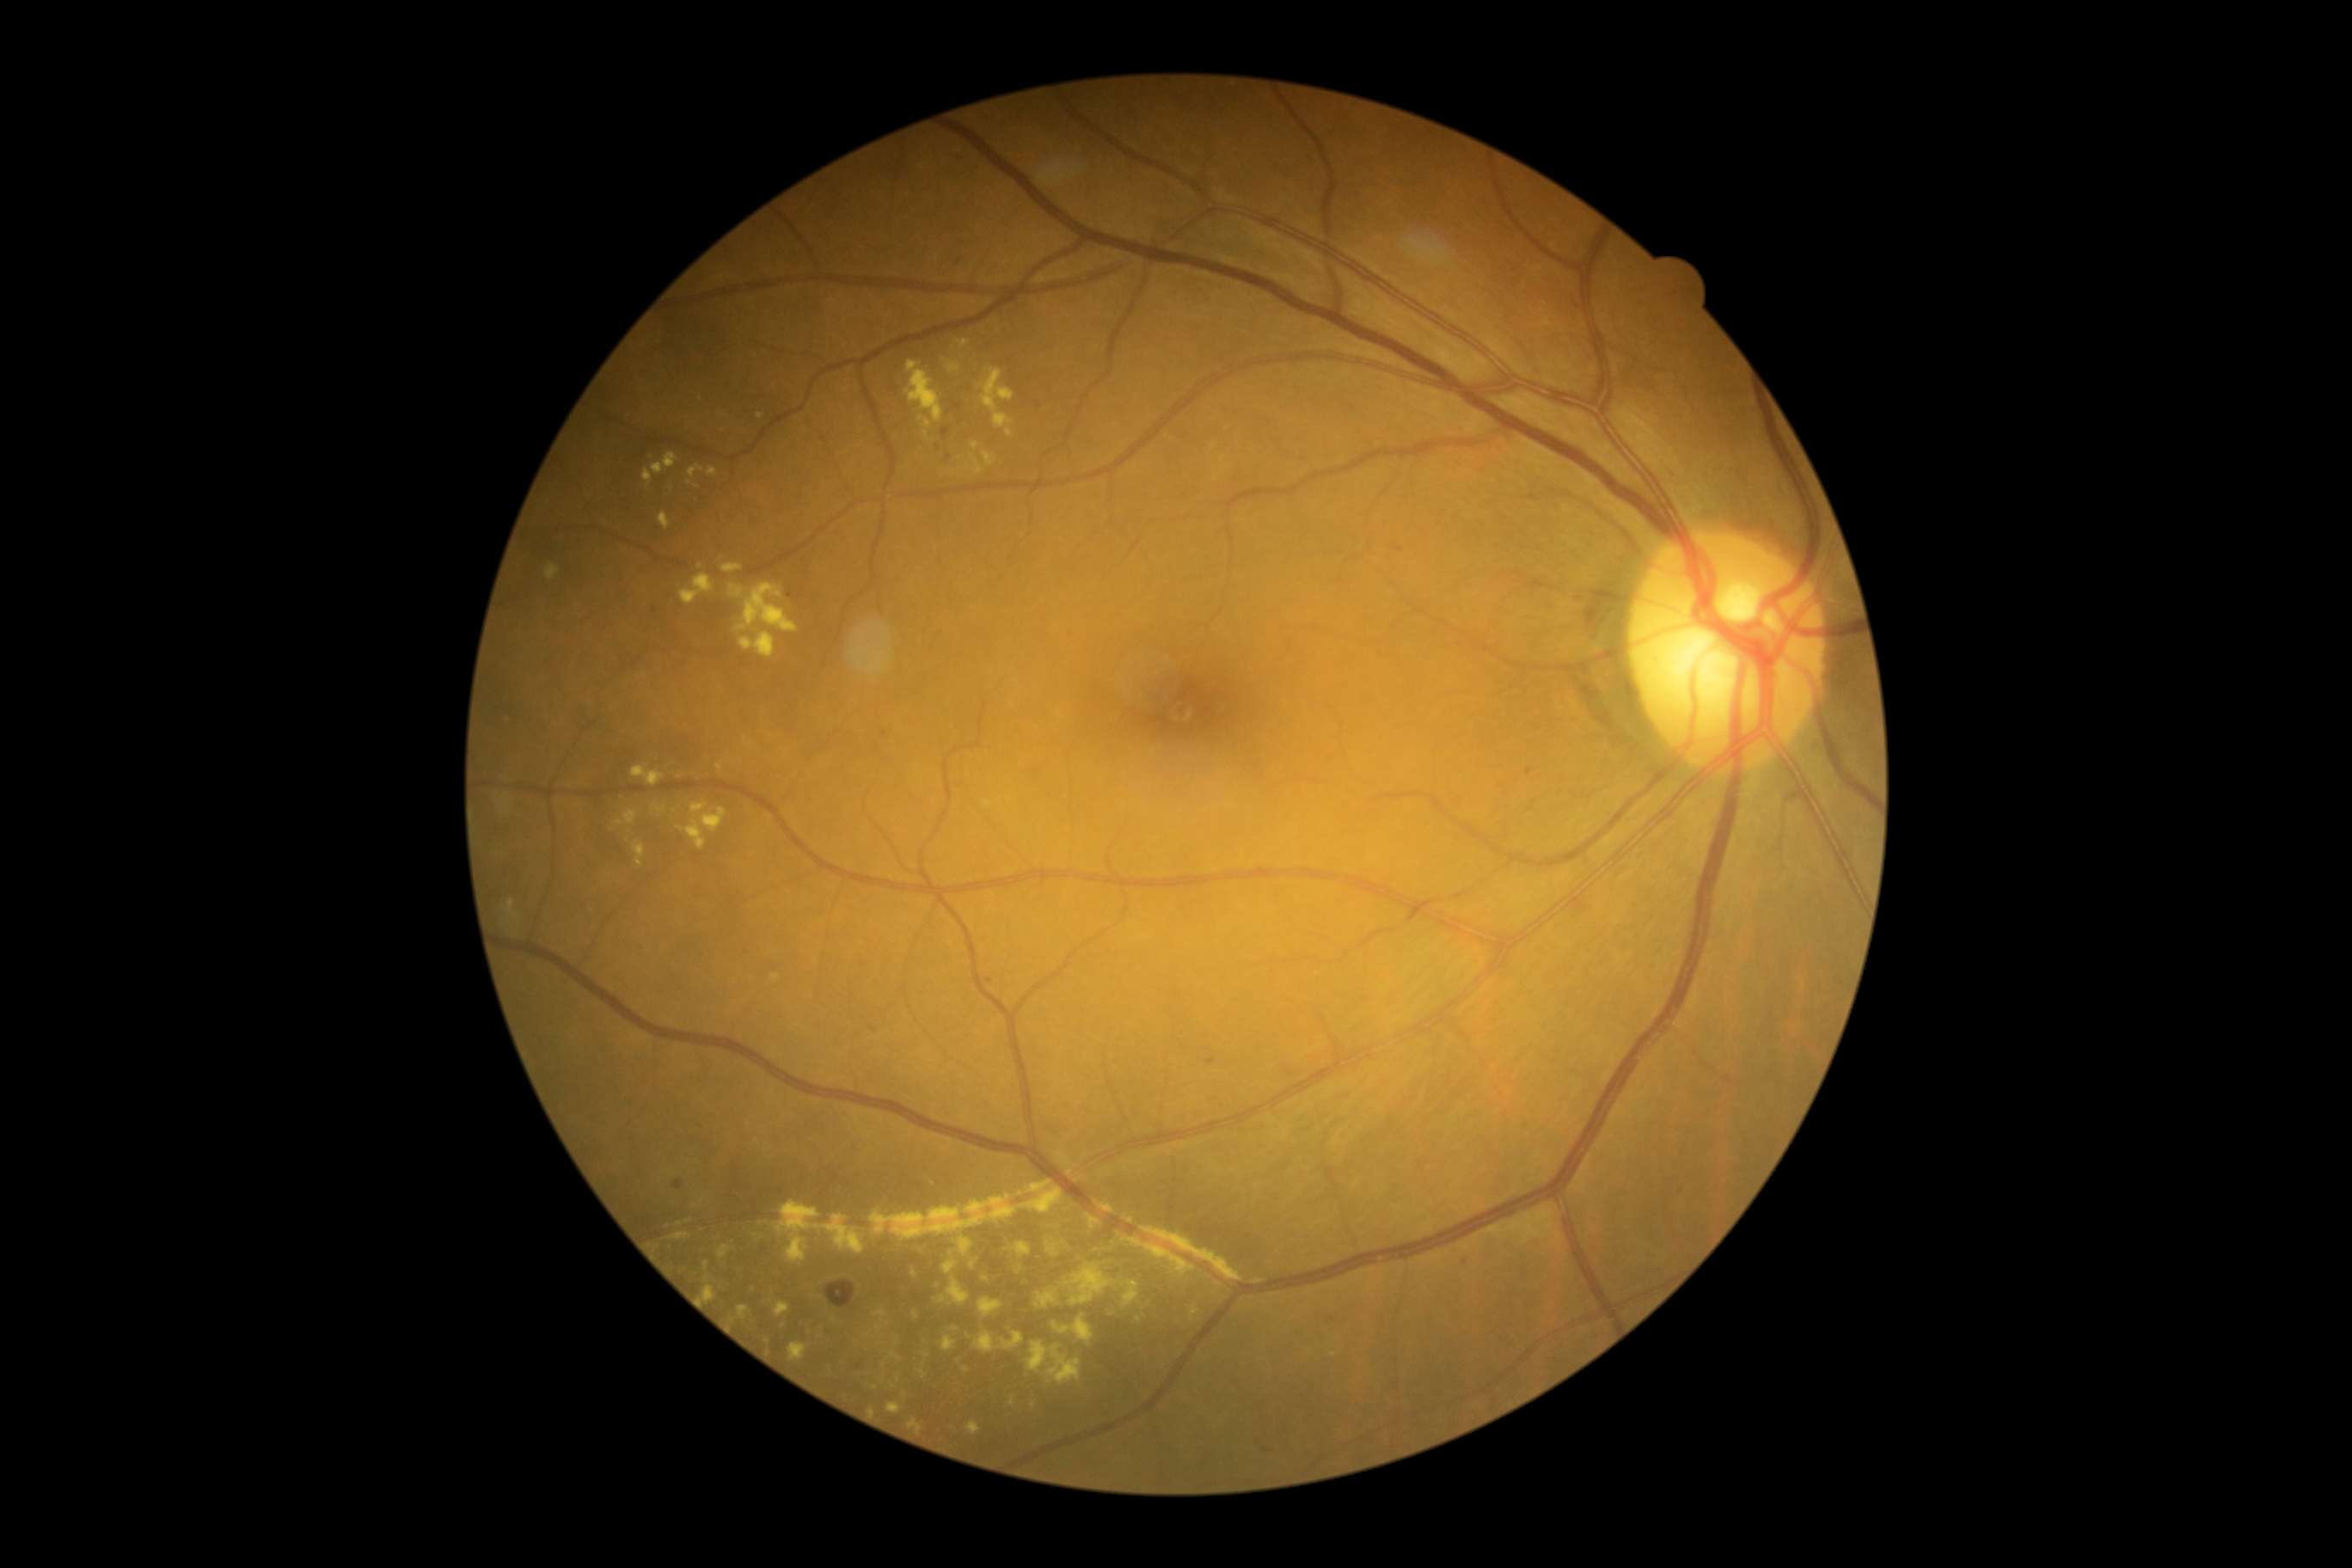
Diabetic retinopathy (DR): grade 2; non-proliferative diabetic retinopathy
A subset of detected lesions:
hard exudates (EXs) (more not shown): rect(1141, 1227, 1240, 1282), rect(1122, 1282, 1139, 1308), rect(979, 369, 1015, 429), rect(1211, 443, 1216, 451), rect(965, 1421, 981, 1436), rect(652, 804, 668, 812), rect(910, 1268, 917, 1278), rect(630, 766, 665, 787), rect(959, 1237, 974, 1256), rect(946, 365, 960, 372), rect(623, 811, 639, 824), rect(644, 469, 652, 489), rect(971, 443, 979, 450)
Small EXs near [x=1139, y=1319], [x=986, y=1279], [x=876, y=1388], [x=699, y=567], [x=628, y=841], [x=883, y=1338]